Retinal fundus photograph — 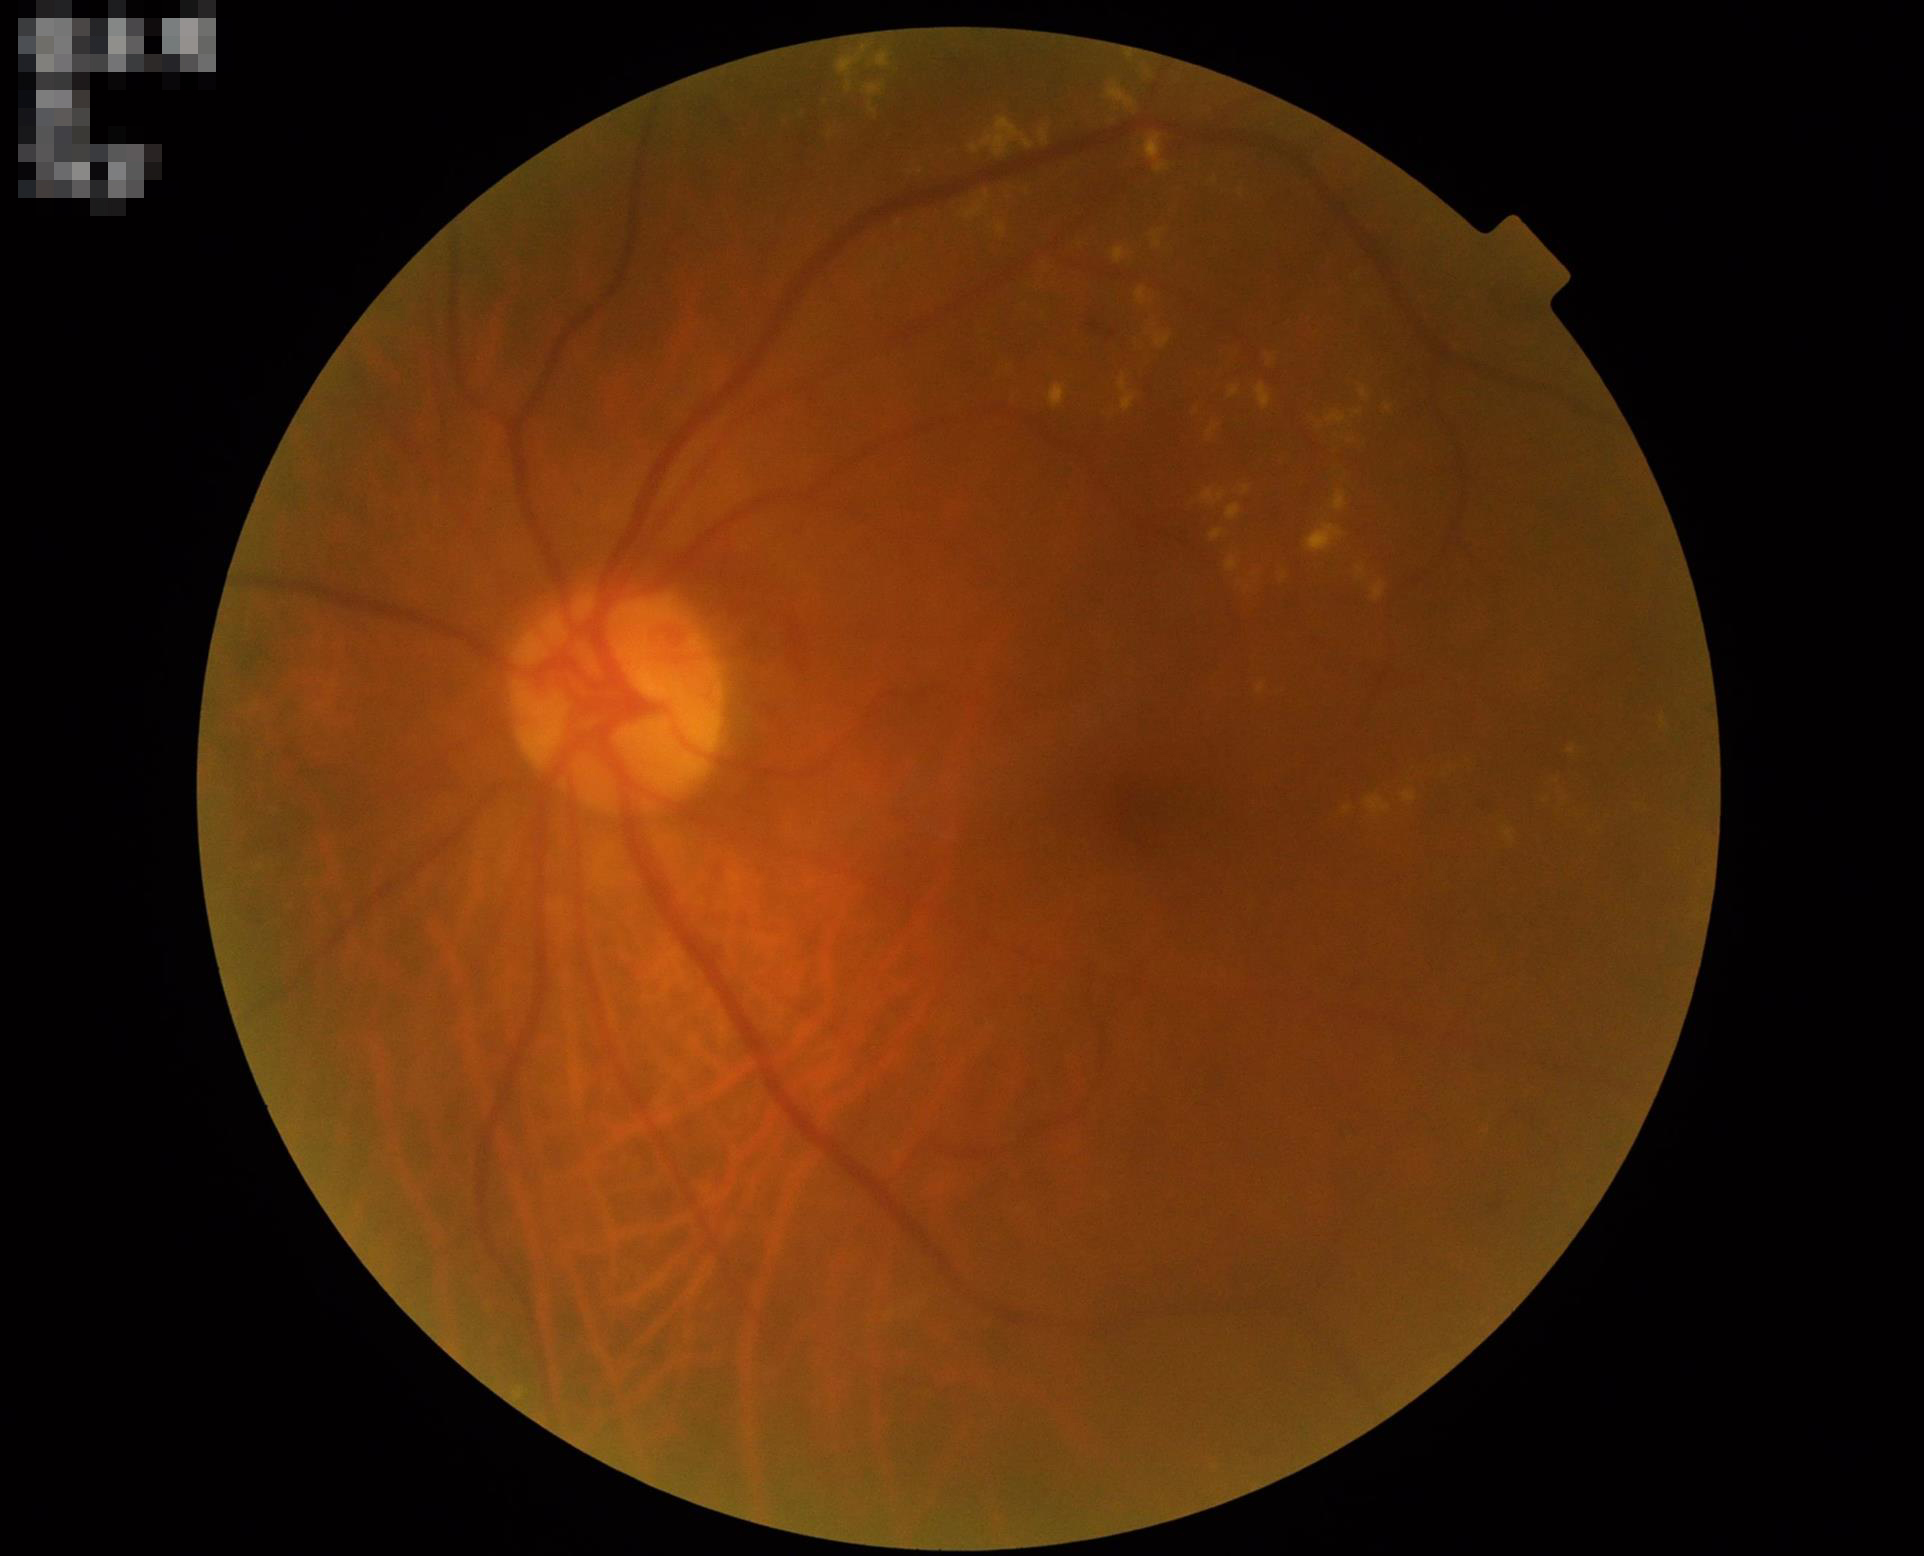
Overall quality is good and the image is gradable. Adequate contrast for distinguishing structures. The image is blurry. Poor illumination with uneven exposure.